1960 by 1897 pixels. Color fundus image. 45-degree field of view.
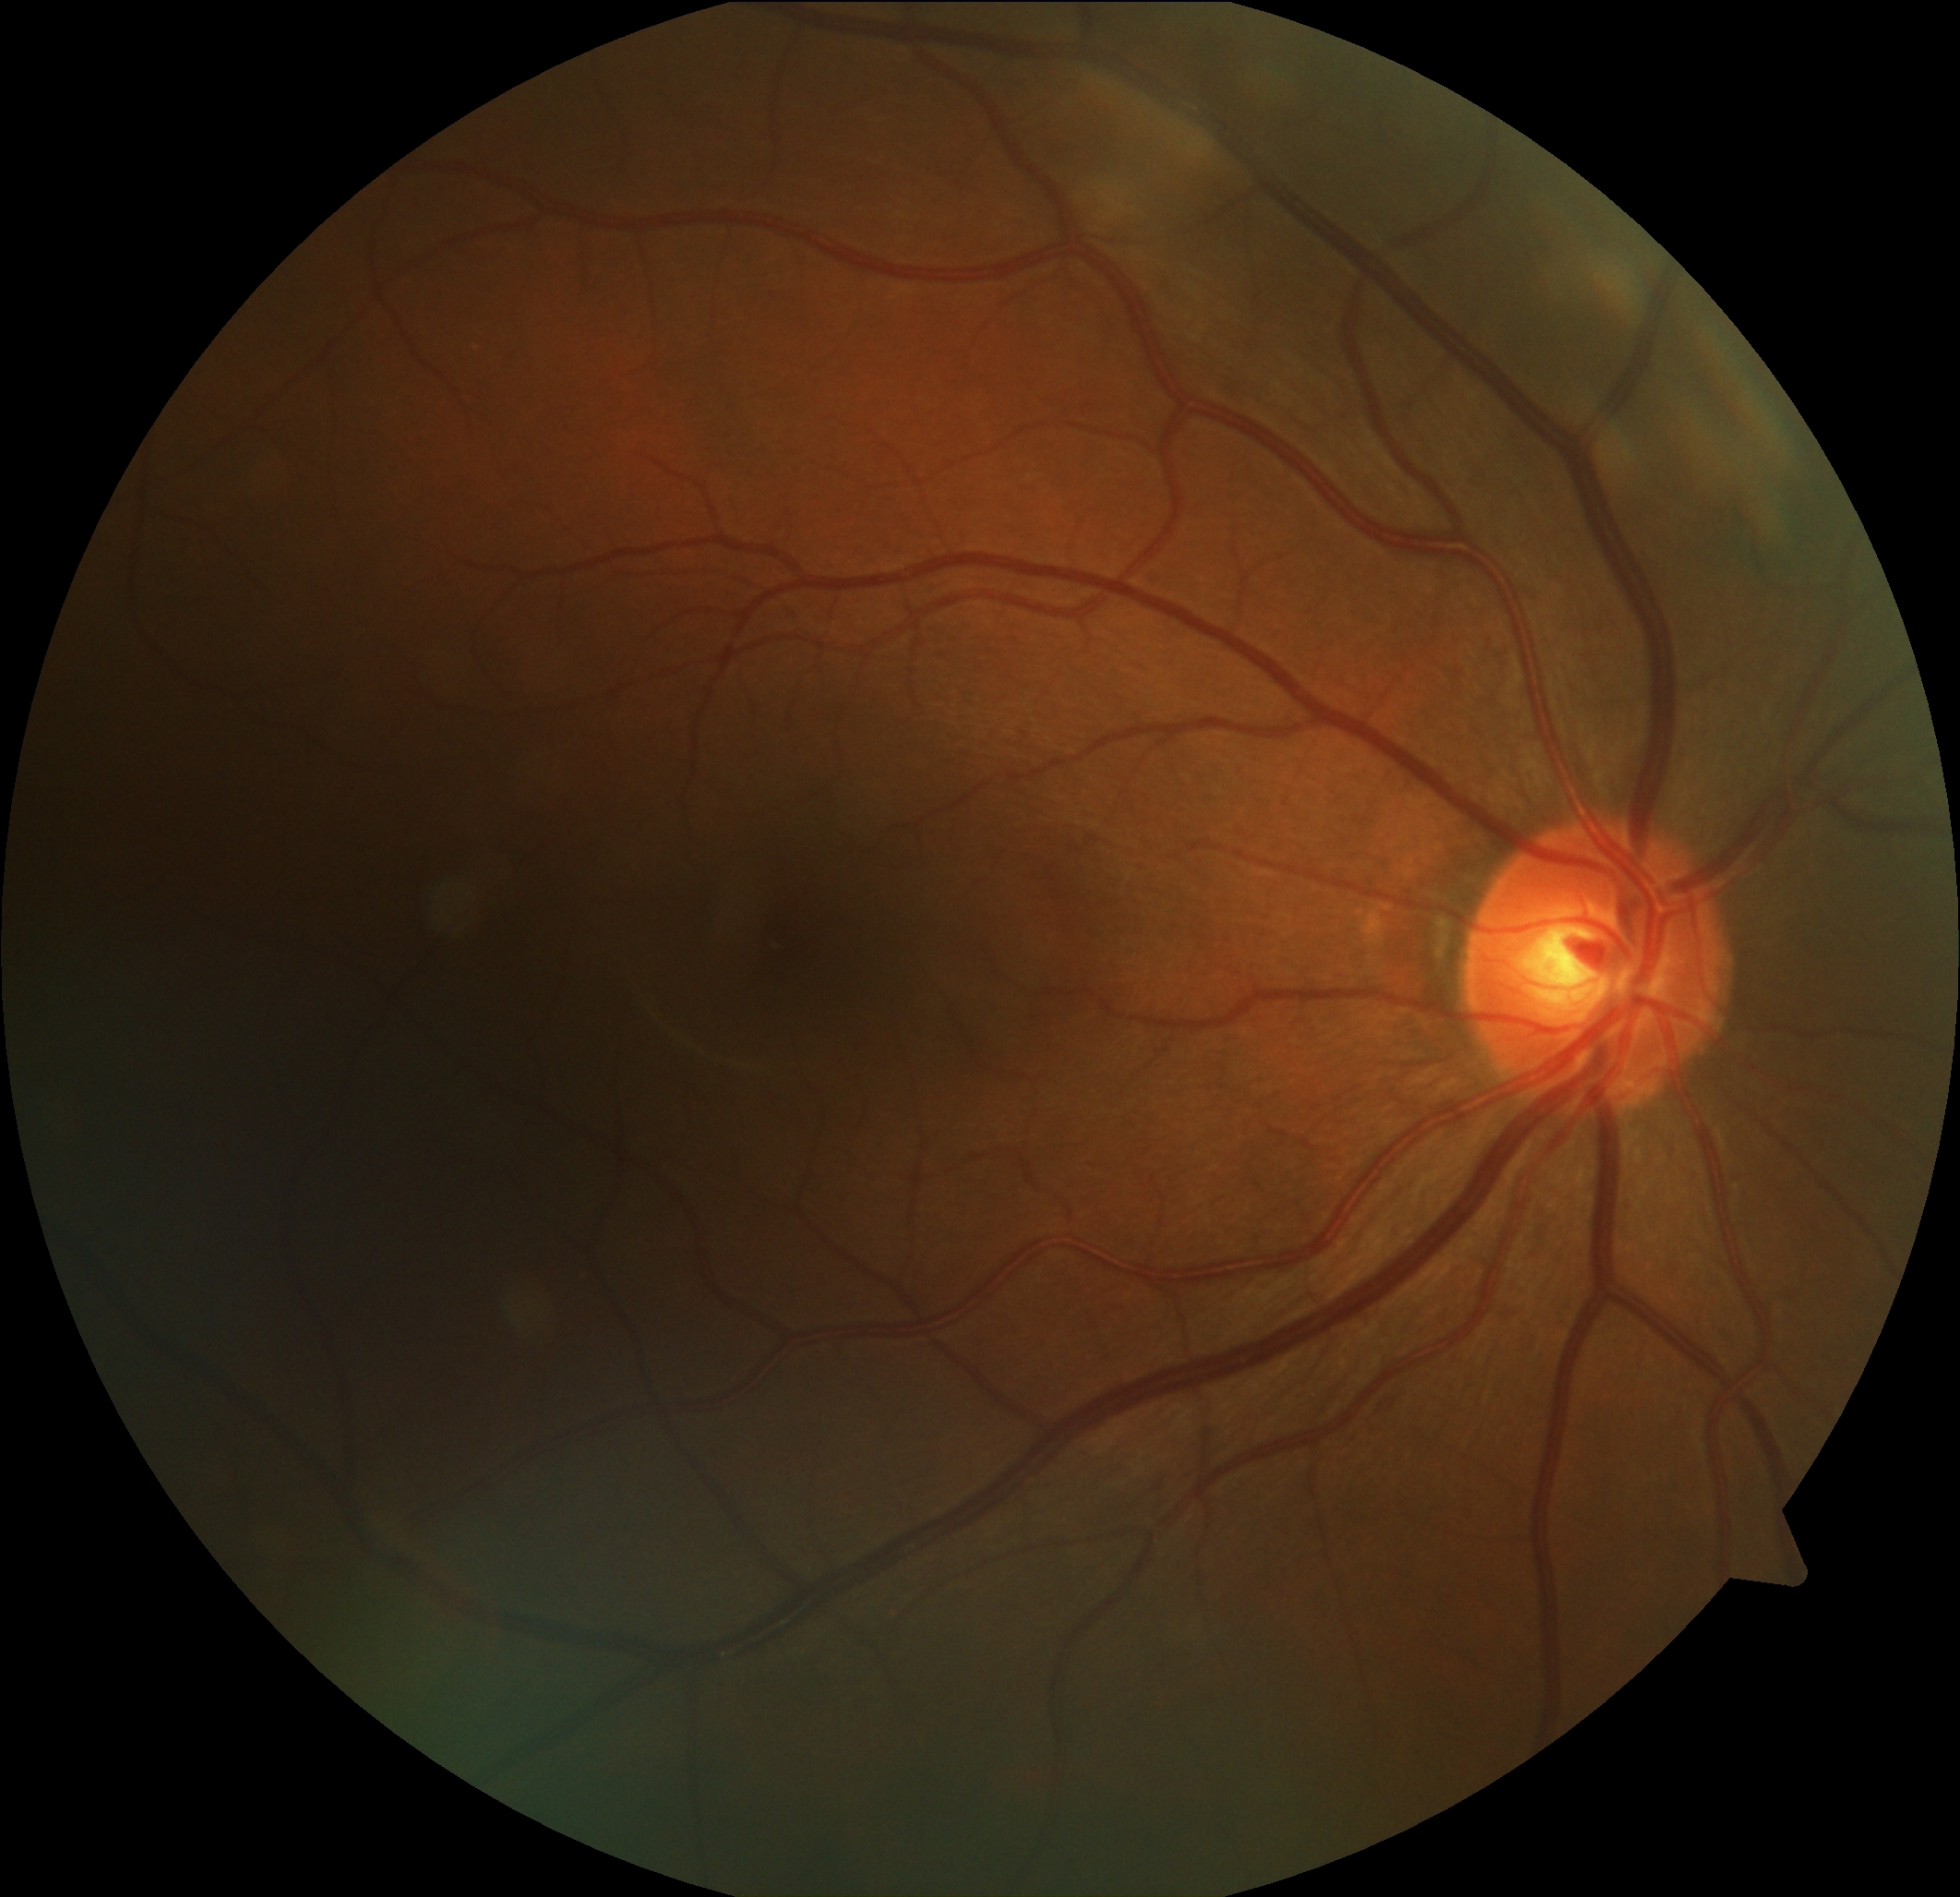

{"dr_grade": "no apparent retinopathy (0)"}